Image size 2352x1568:
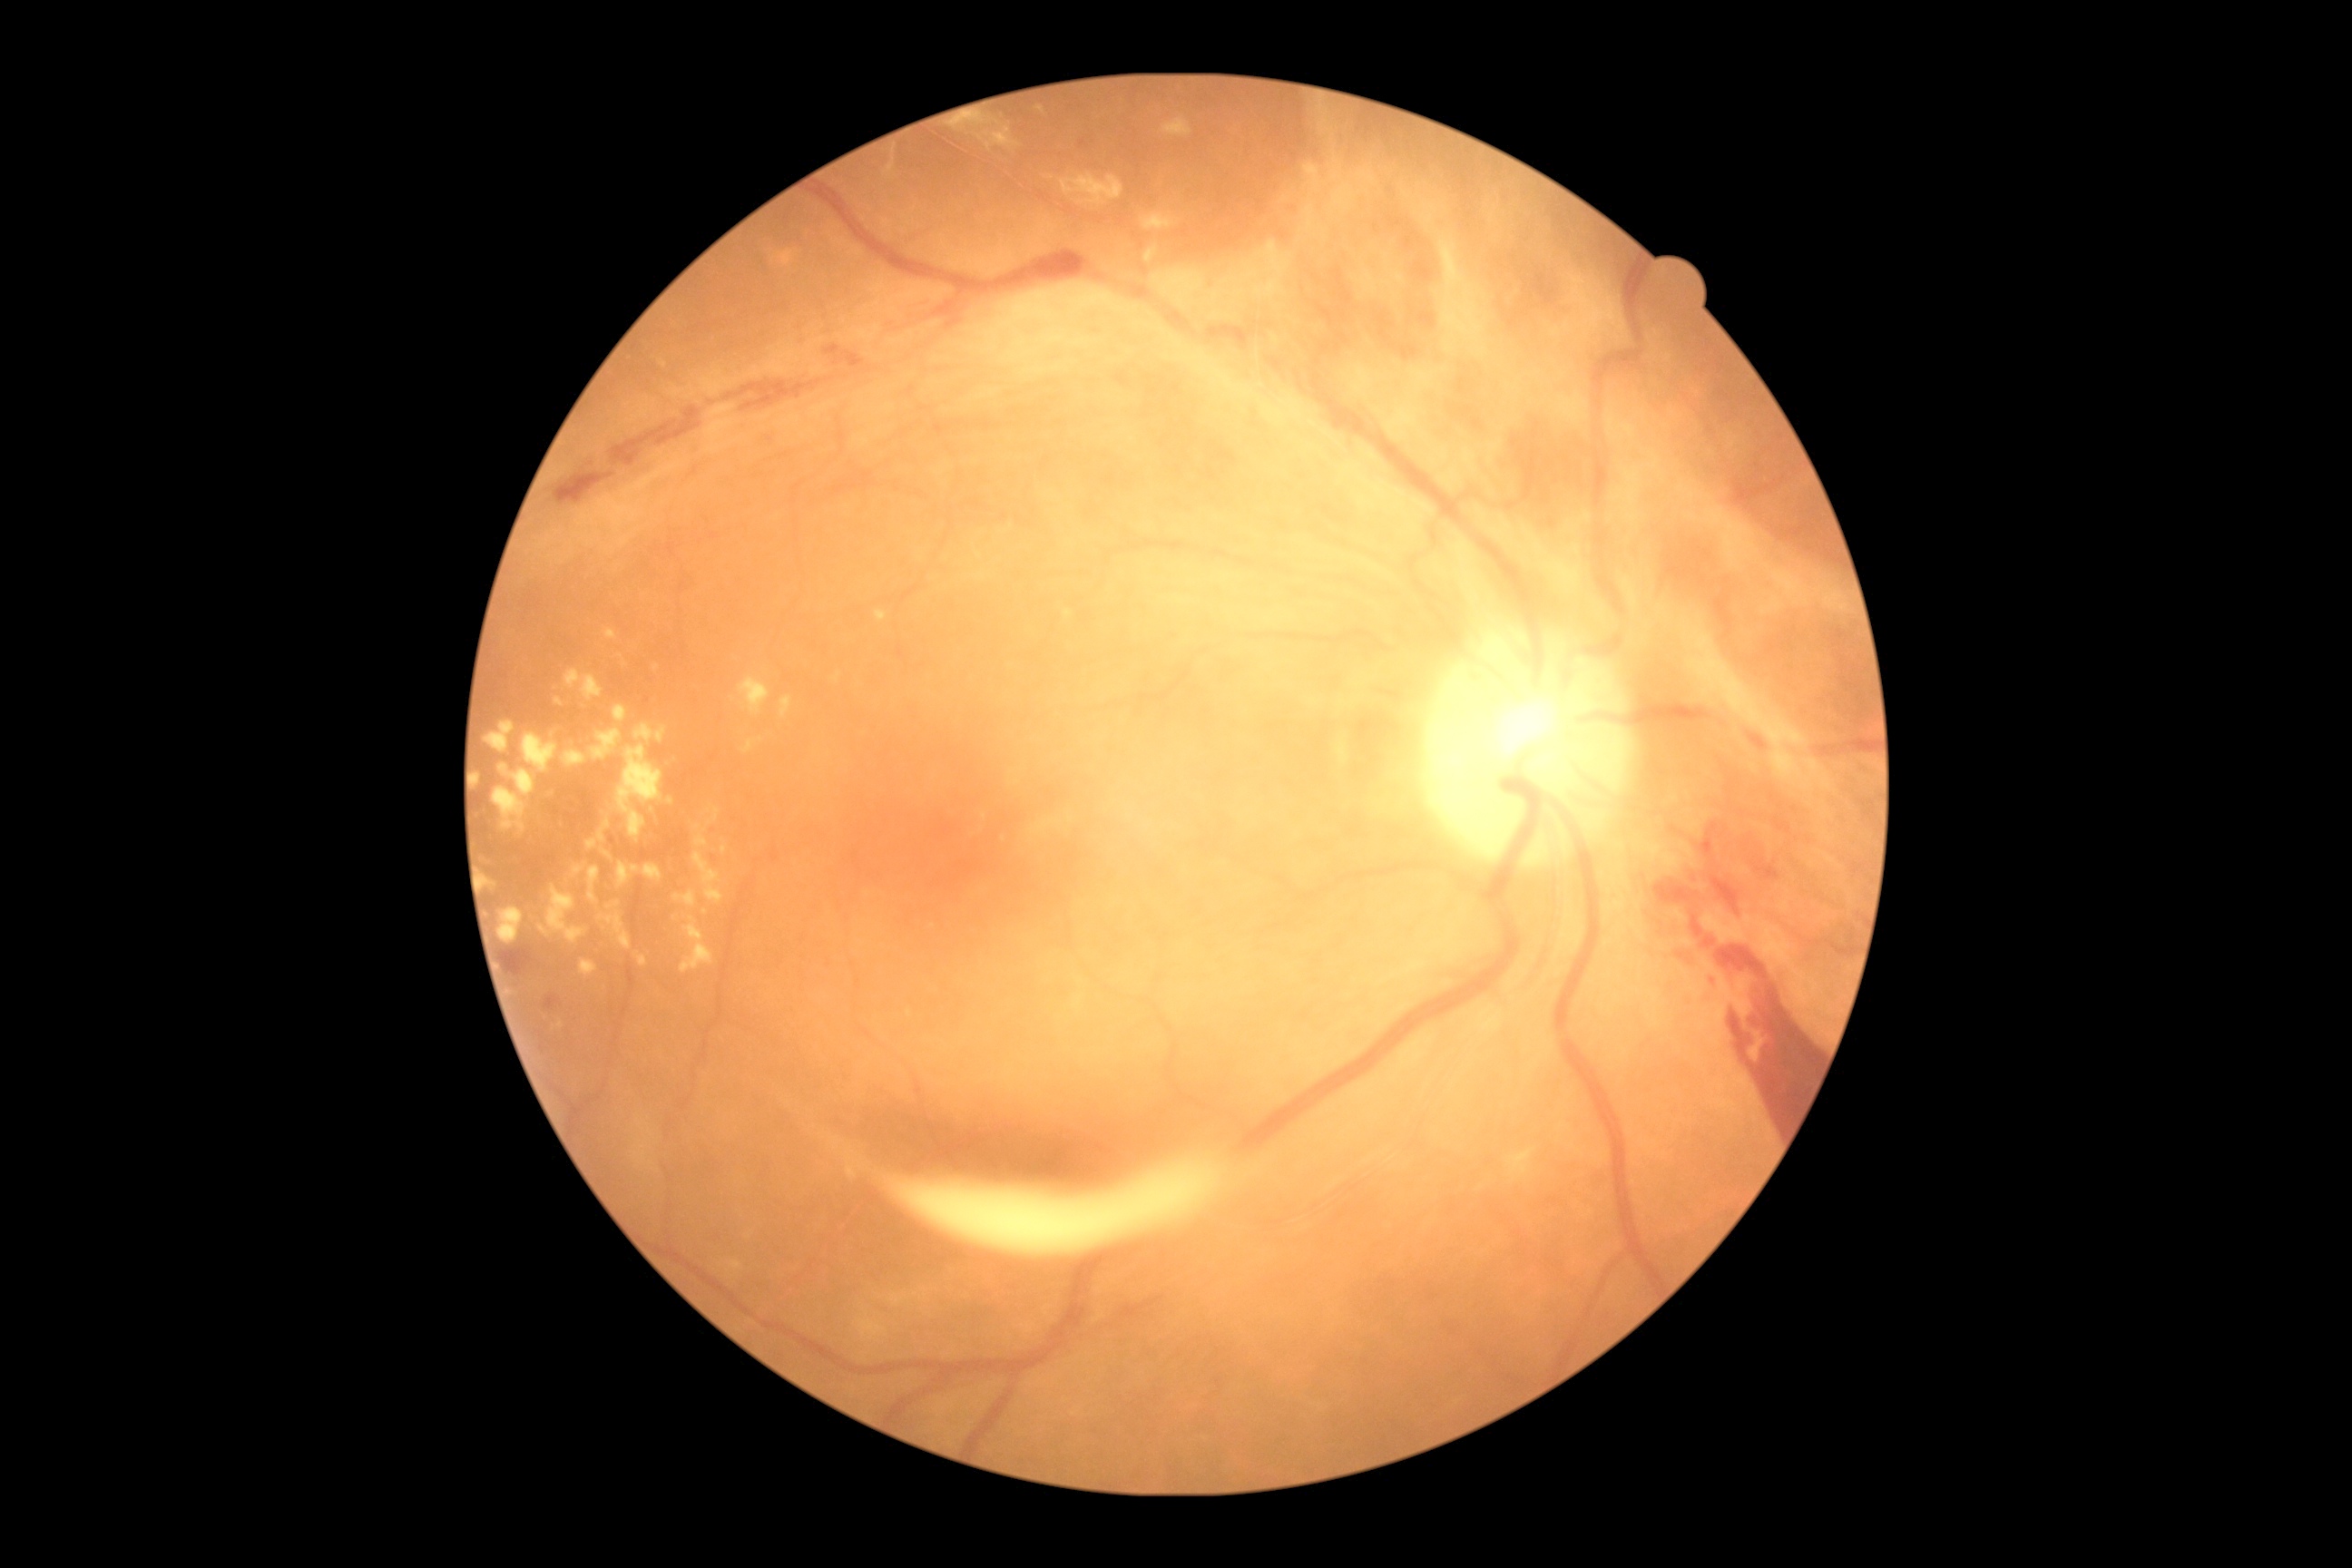 Diabetic retinopathy (DR) is proliferative diabetic retinopathy (grade 4). Hard exudates (EXs) include rect(781, 696, 792, 718), rect(1044, 177, 1054, 181), rect(500, 765, 536, 798), rect(636, 952, 647, 968), rect(834, 674, 841, 683), rect(634, 725, 667, 745), rect(485, 877, 496, 888), rect(547, 885, 587, 943), rect(694, 852, 725, 905), rect(994, 128, 1021, 148), rect(498, 908, 524, 943), rect(564, 750, 587, 767), rect(612, 705, 629, 723), rect(876, 612, 888, 622). Small EXs approximately at point(724, 850), point(980, 555), point(761, 739).